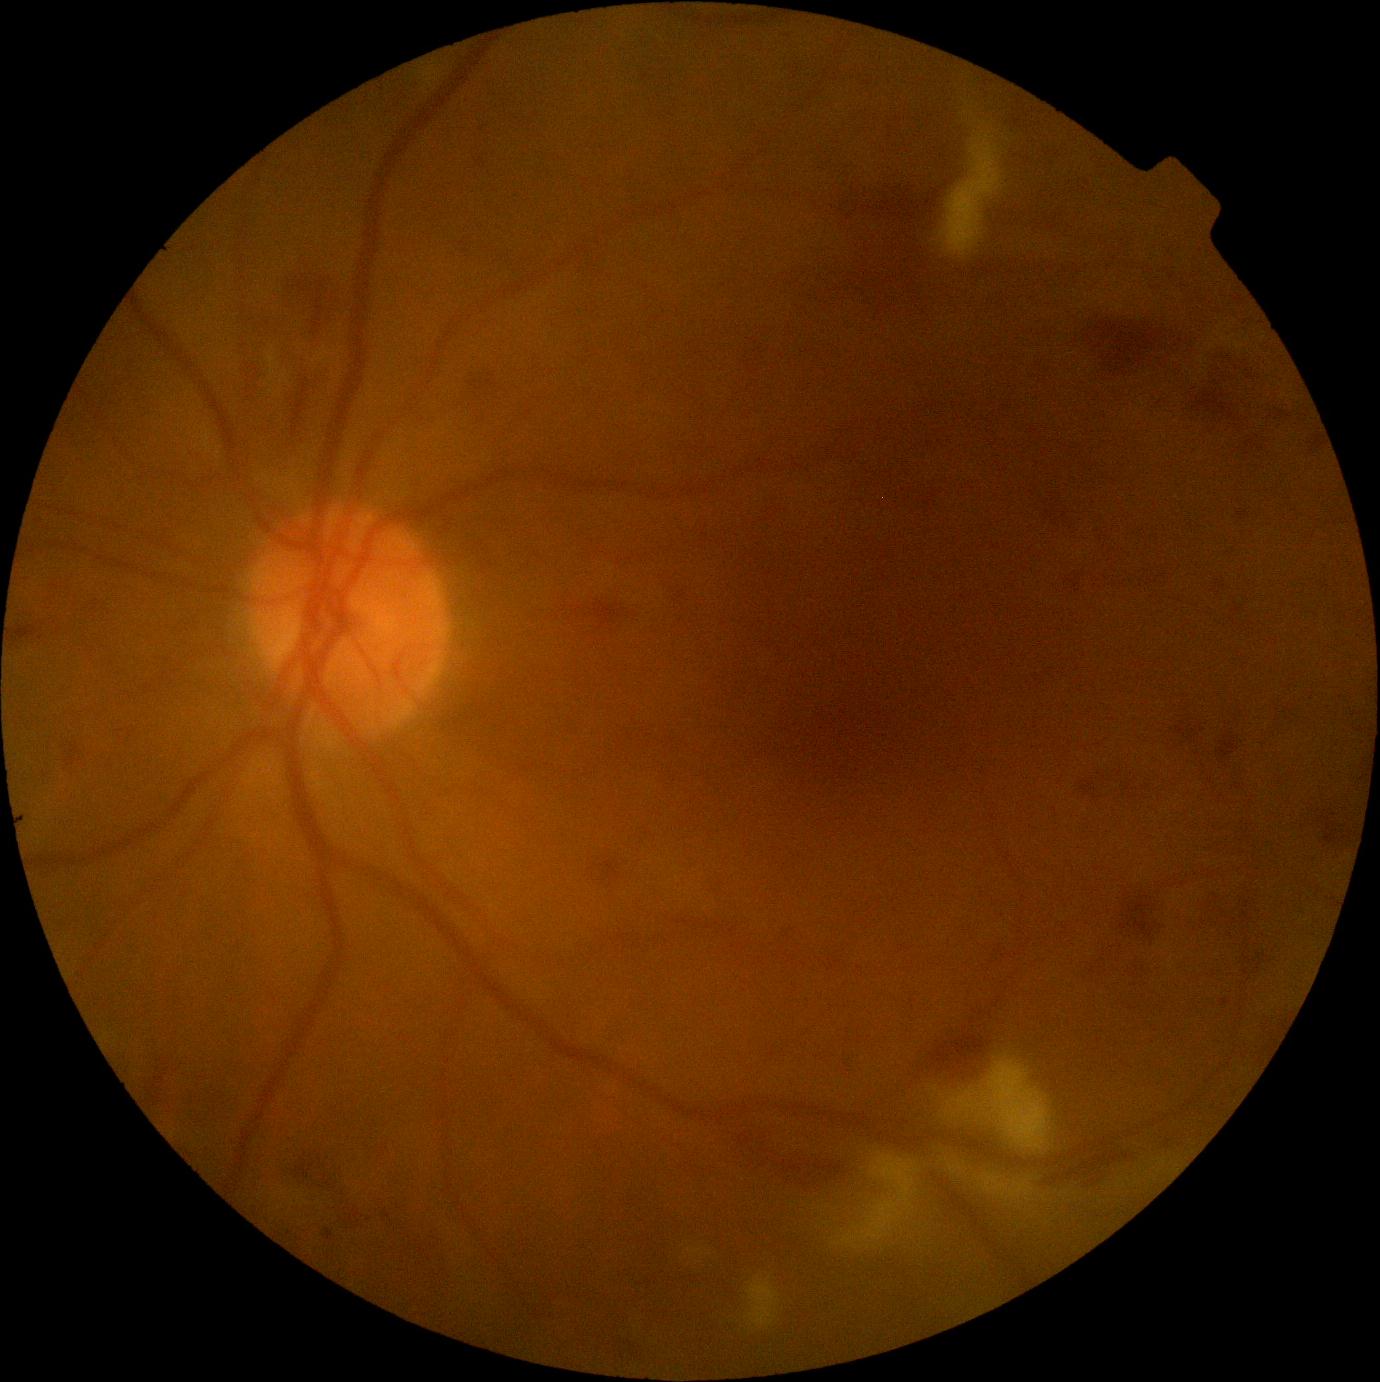 Retinopathy: grade 3 (severe NPDR). Disease class: non-proliferative diabetic retinopathy.